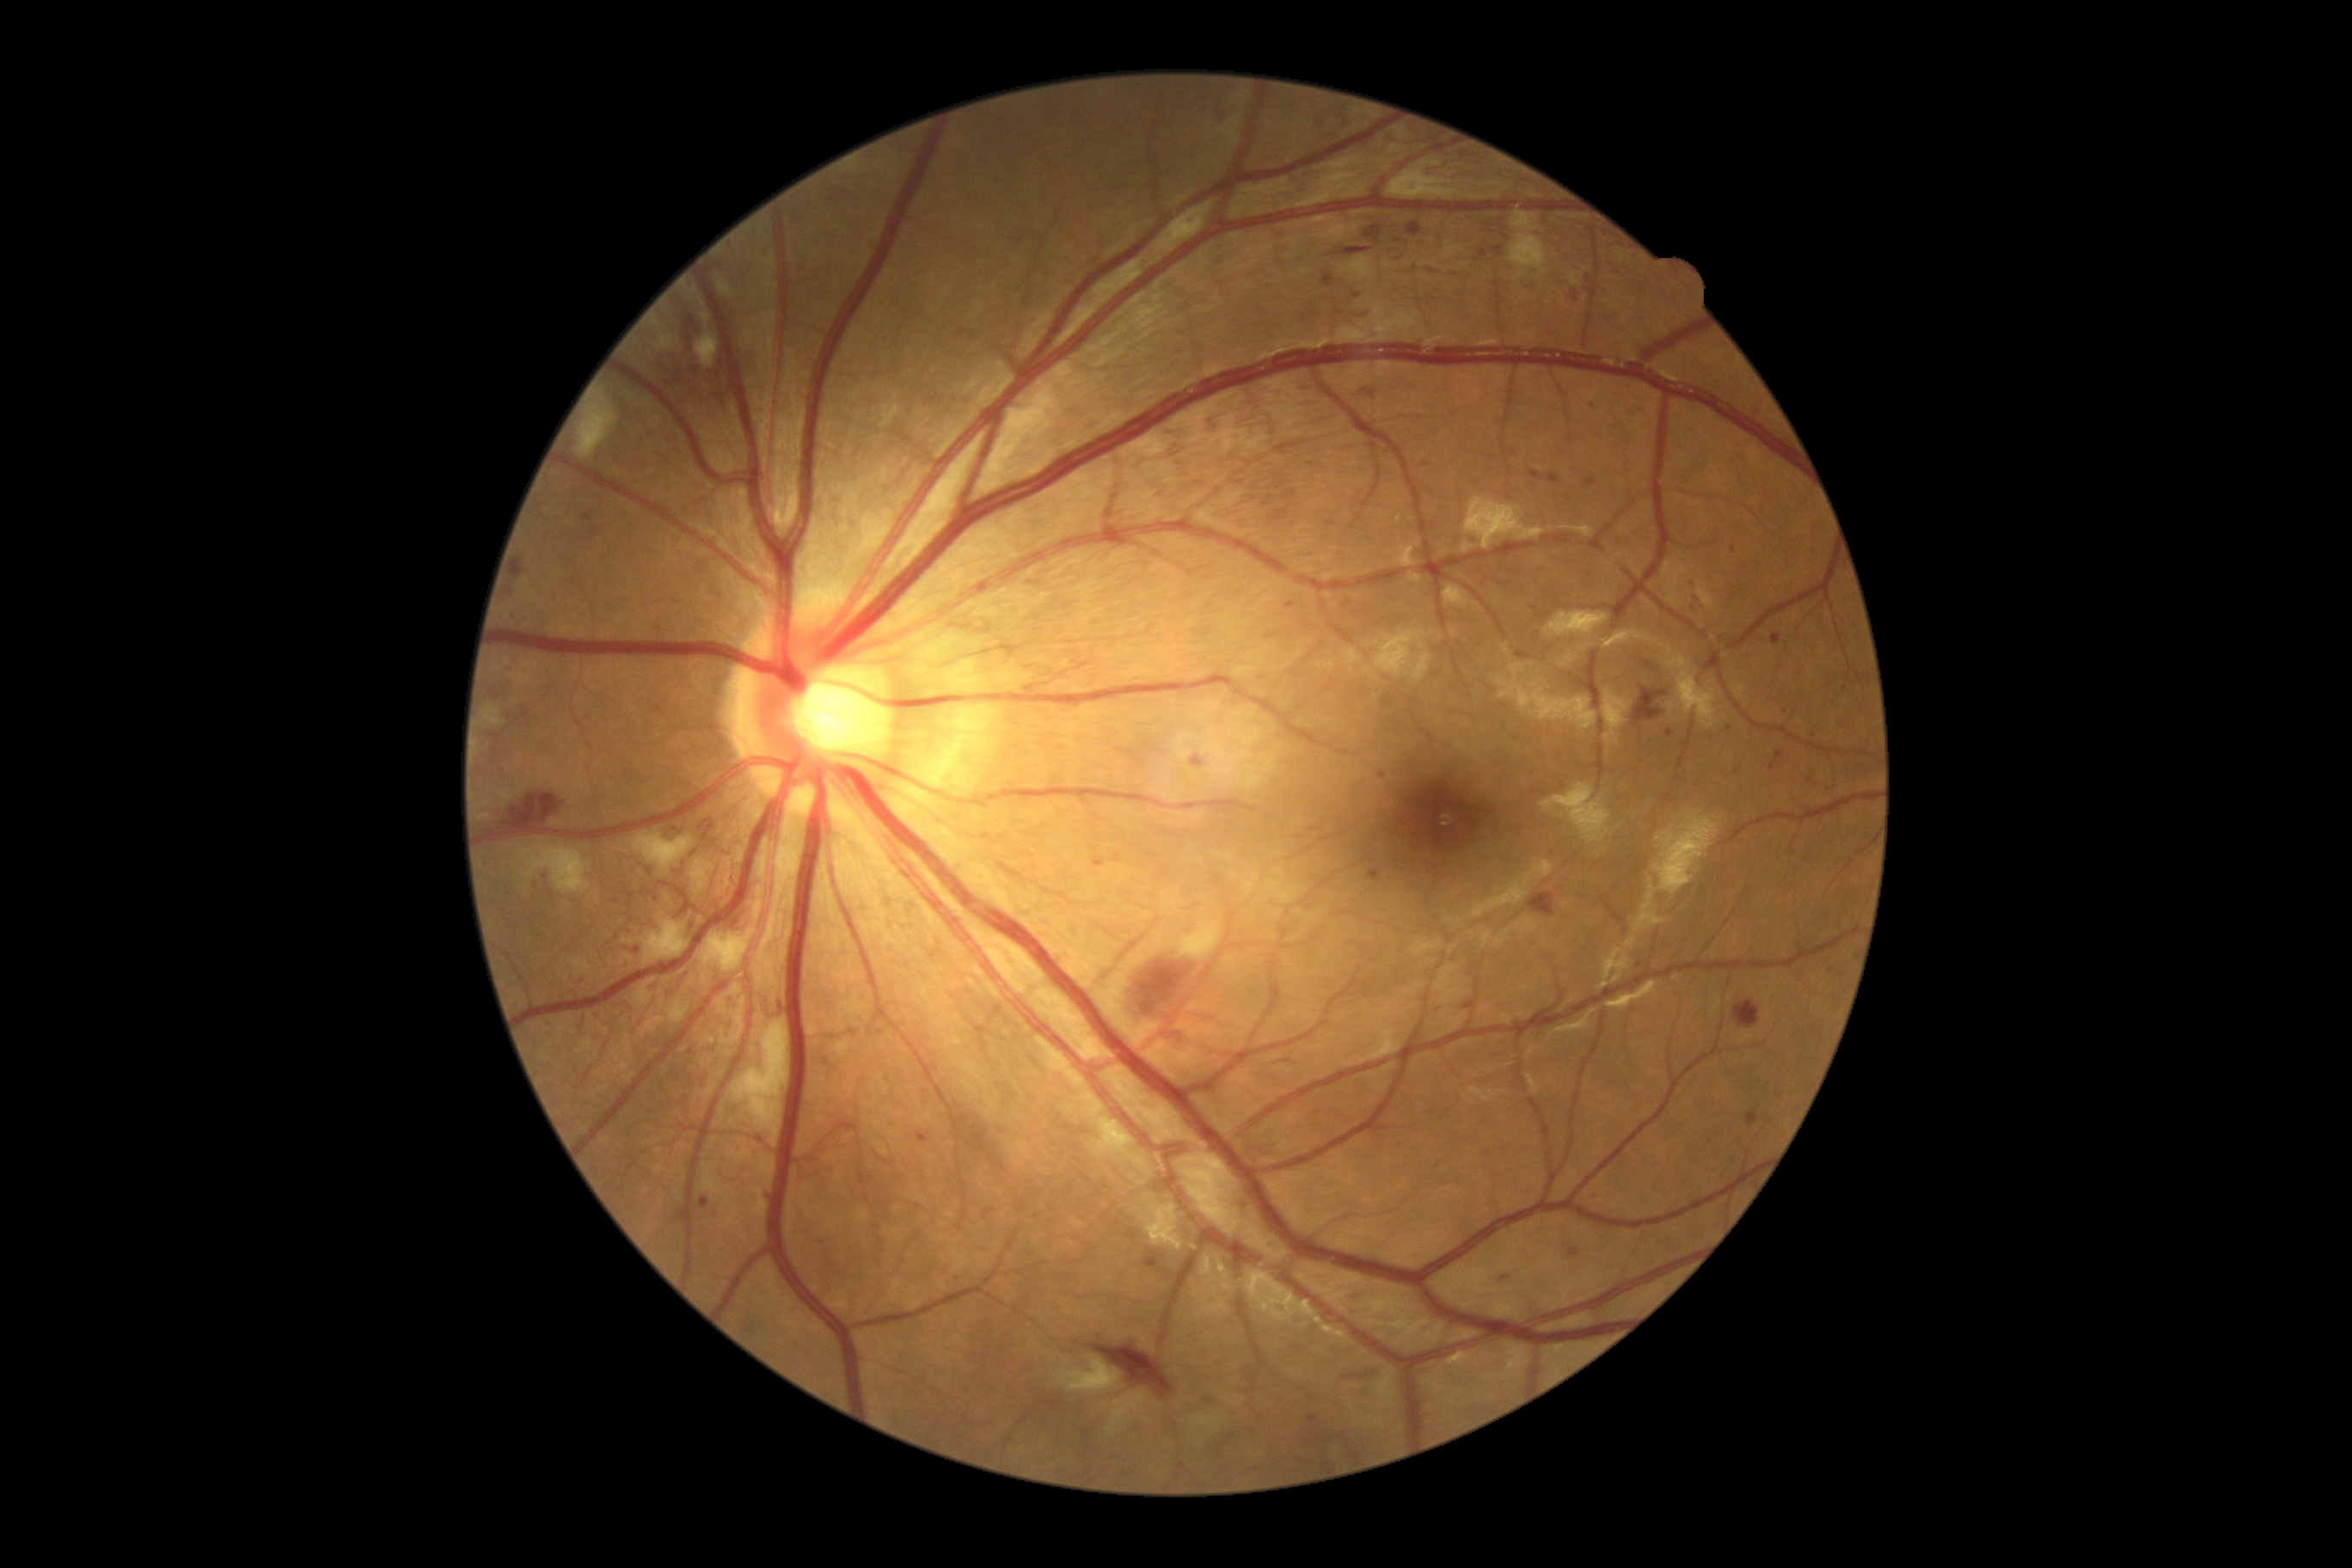

Diabetic retinopathy (DR) is 3/4 — more than 20 intraretinal hemorrhages in each of 4 quadrants, definite venous beading in 2 or more quadrants, or prominent intraretinal microvascular abnormalities in 1 or more quadrants, with no signs of proliferative retinopathy. Hemorrhages (HEs) include those at [1746, 1112, 1760, 1129]; [1428, 168, 1440, 178]; [1512, 568, 1524, 577]; [1340, 443, 1357, 455]; [917, 1134, 928, 1144]; [1646, 661, 1655, 670]; [510, 609, 525, 627]; [1464, 567, 1521, 585]; [511, 554, 530, 580]; [1314, 448, 1325, 456]; [1294, 386, 1316, 393]; [1686, 426, 1701, 438]; [1211, 254, 1227, 266]. Additional small HEs near 1810, 781; 1253, 498; 495, 755; 1832, 972; 637, 949; 1772, 767.